2091 by 1764 pixels:
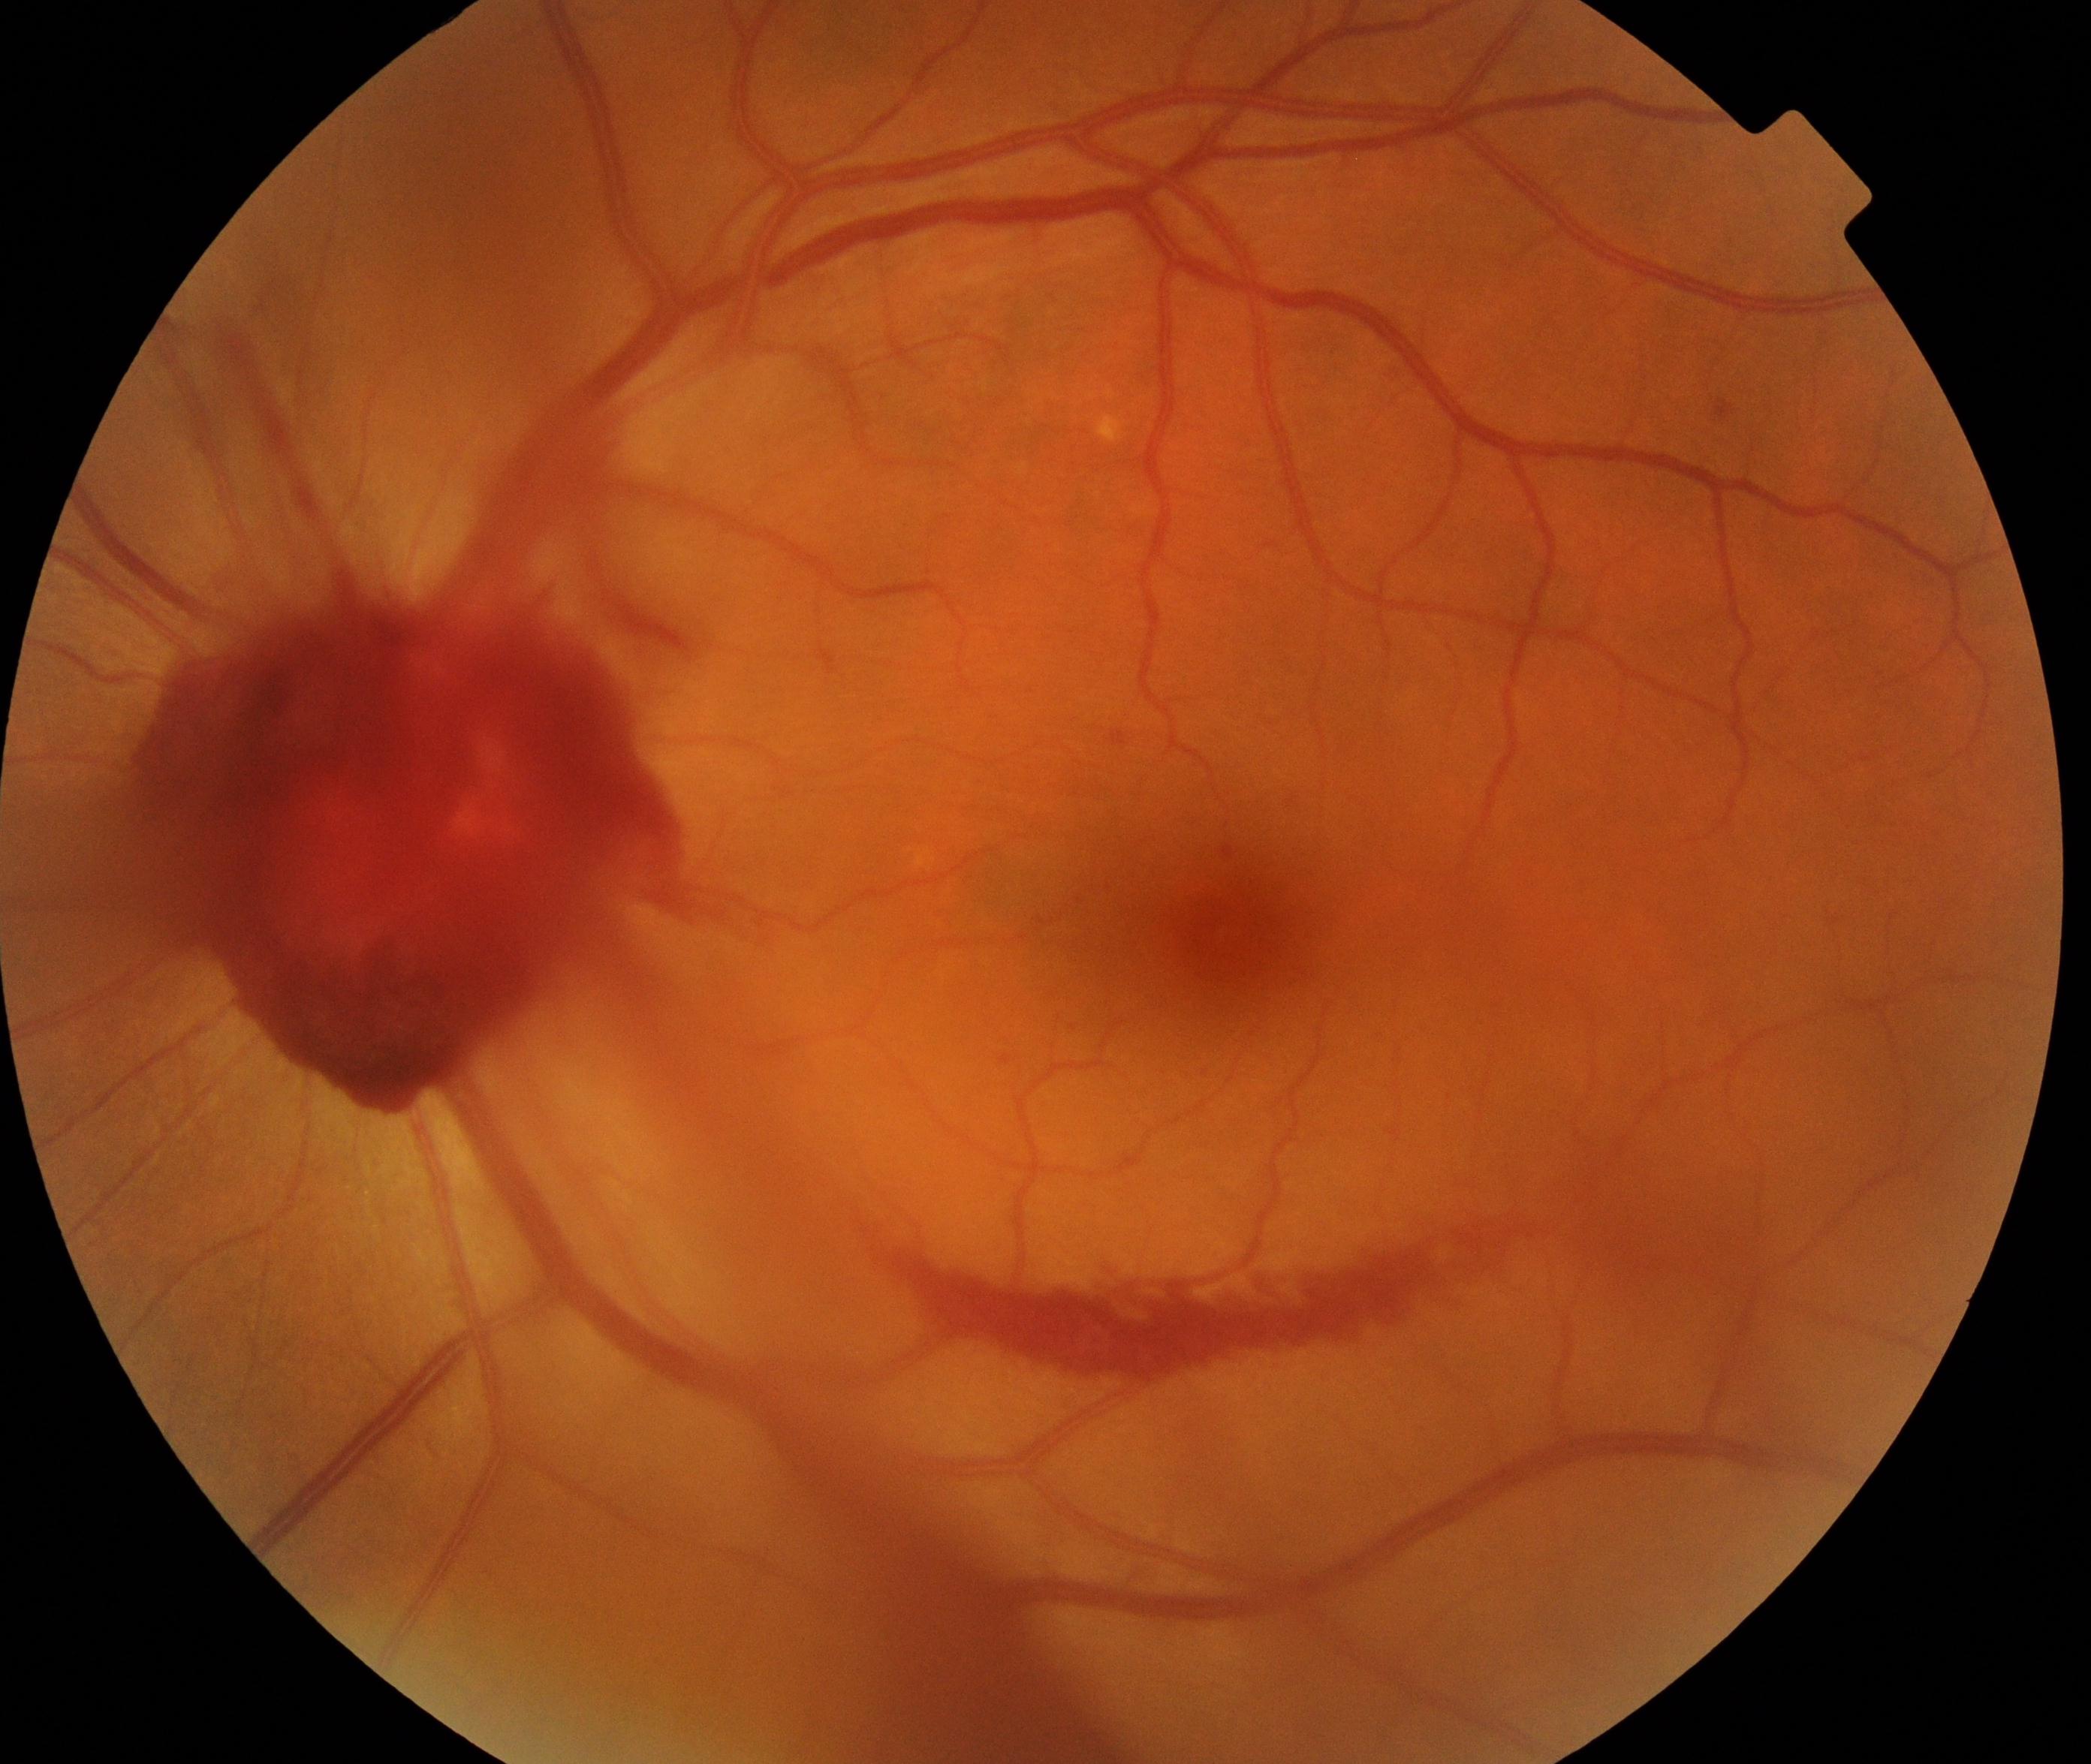
Impression: preretinal hemorrhage.